Camera: NIDEK AFC-230:
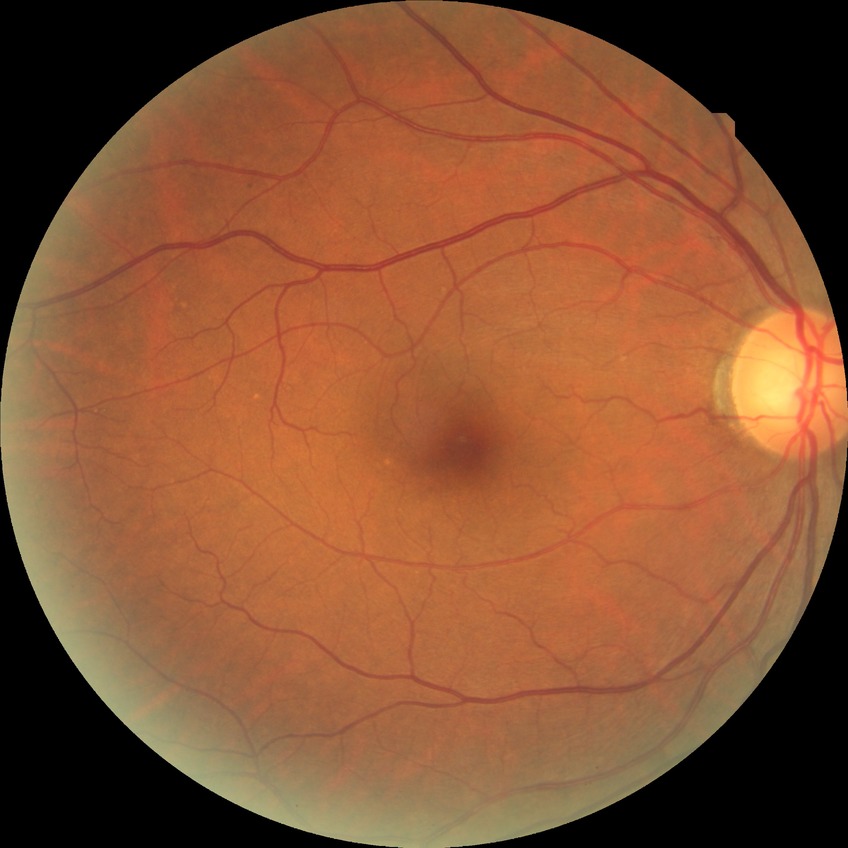
Diabetic retinopathy (DR): simple diabetic retinopathy (SDR).